Wide-field fundus image from infant ROP screening; image size 1440x1080; Natus RetCam Envision, 130° FOV:
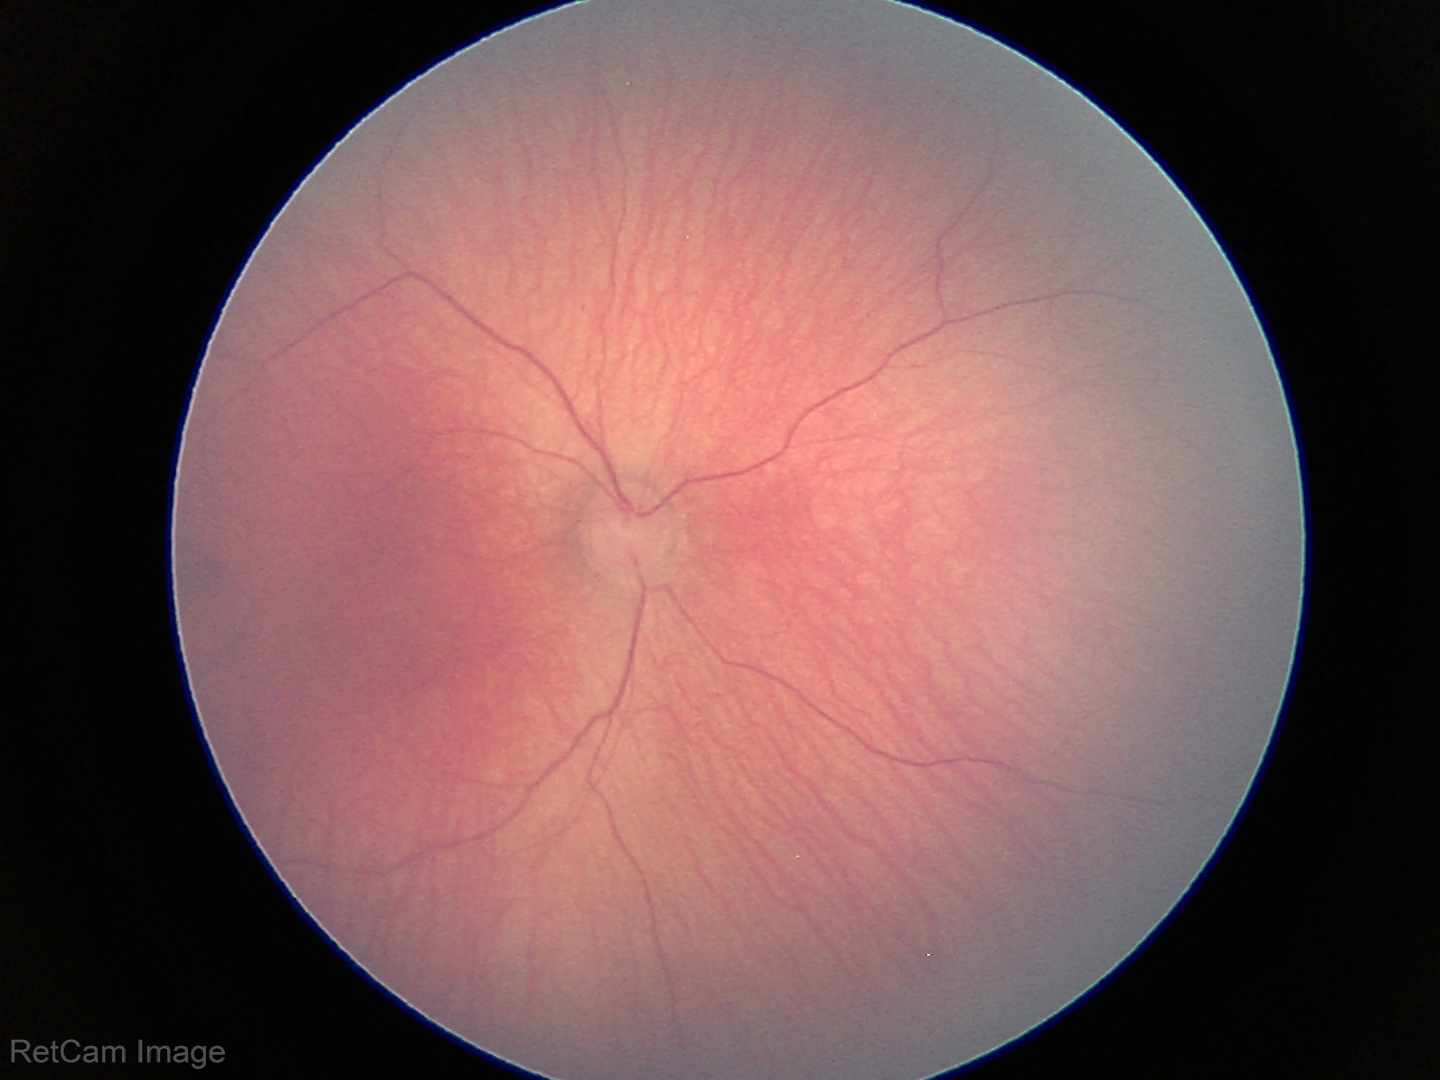 Normal screening examination.